Captured after pupil dilation: 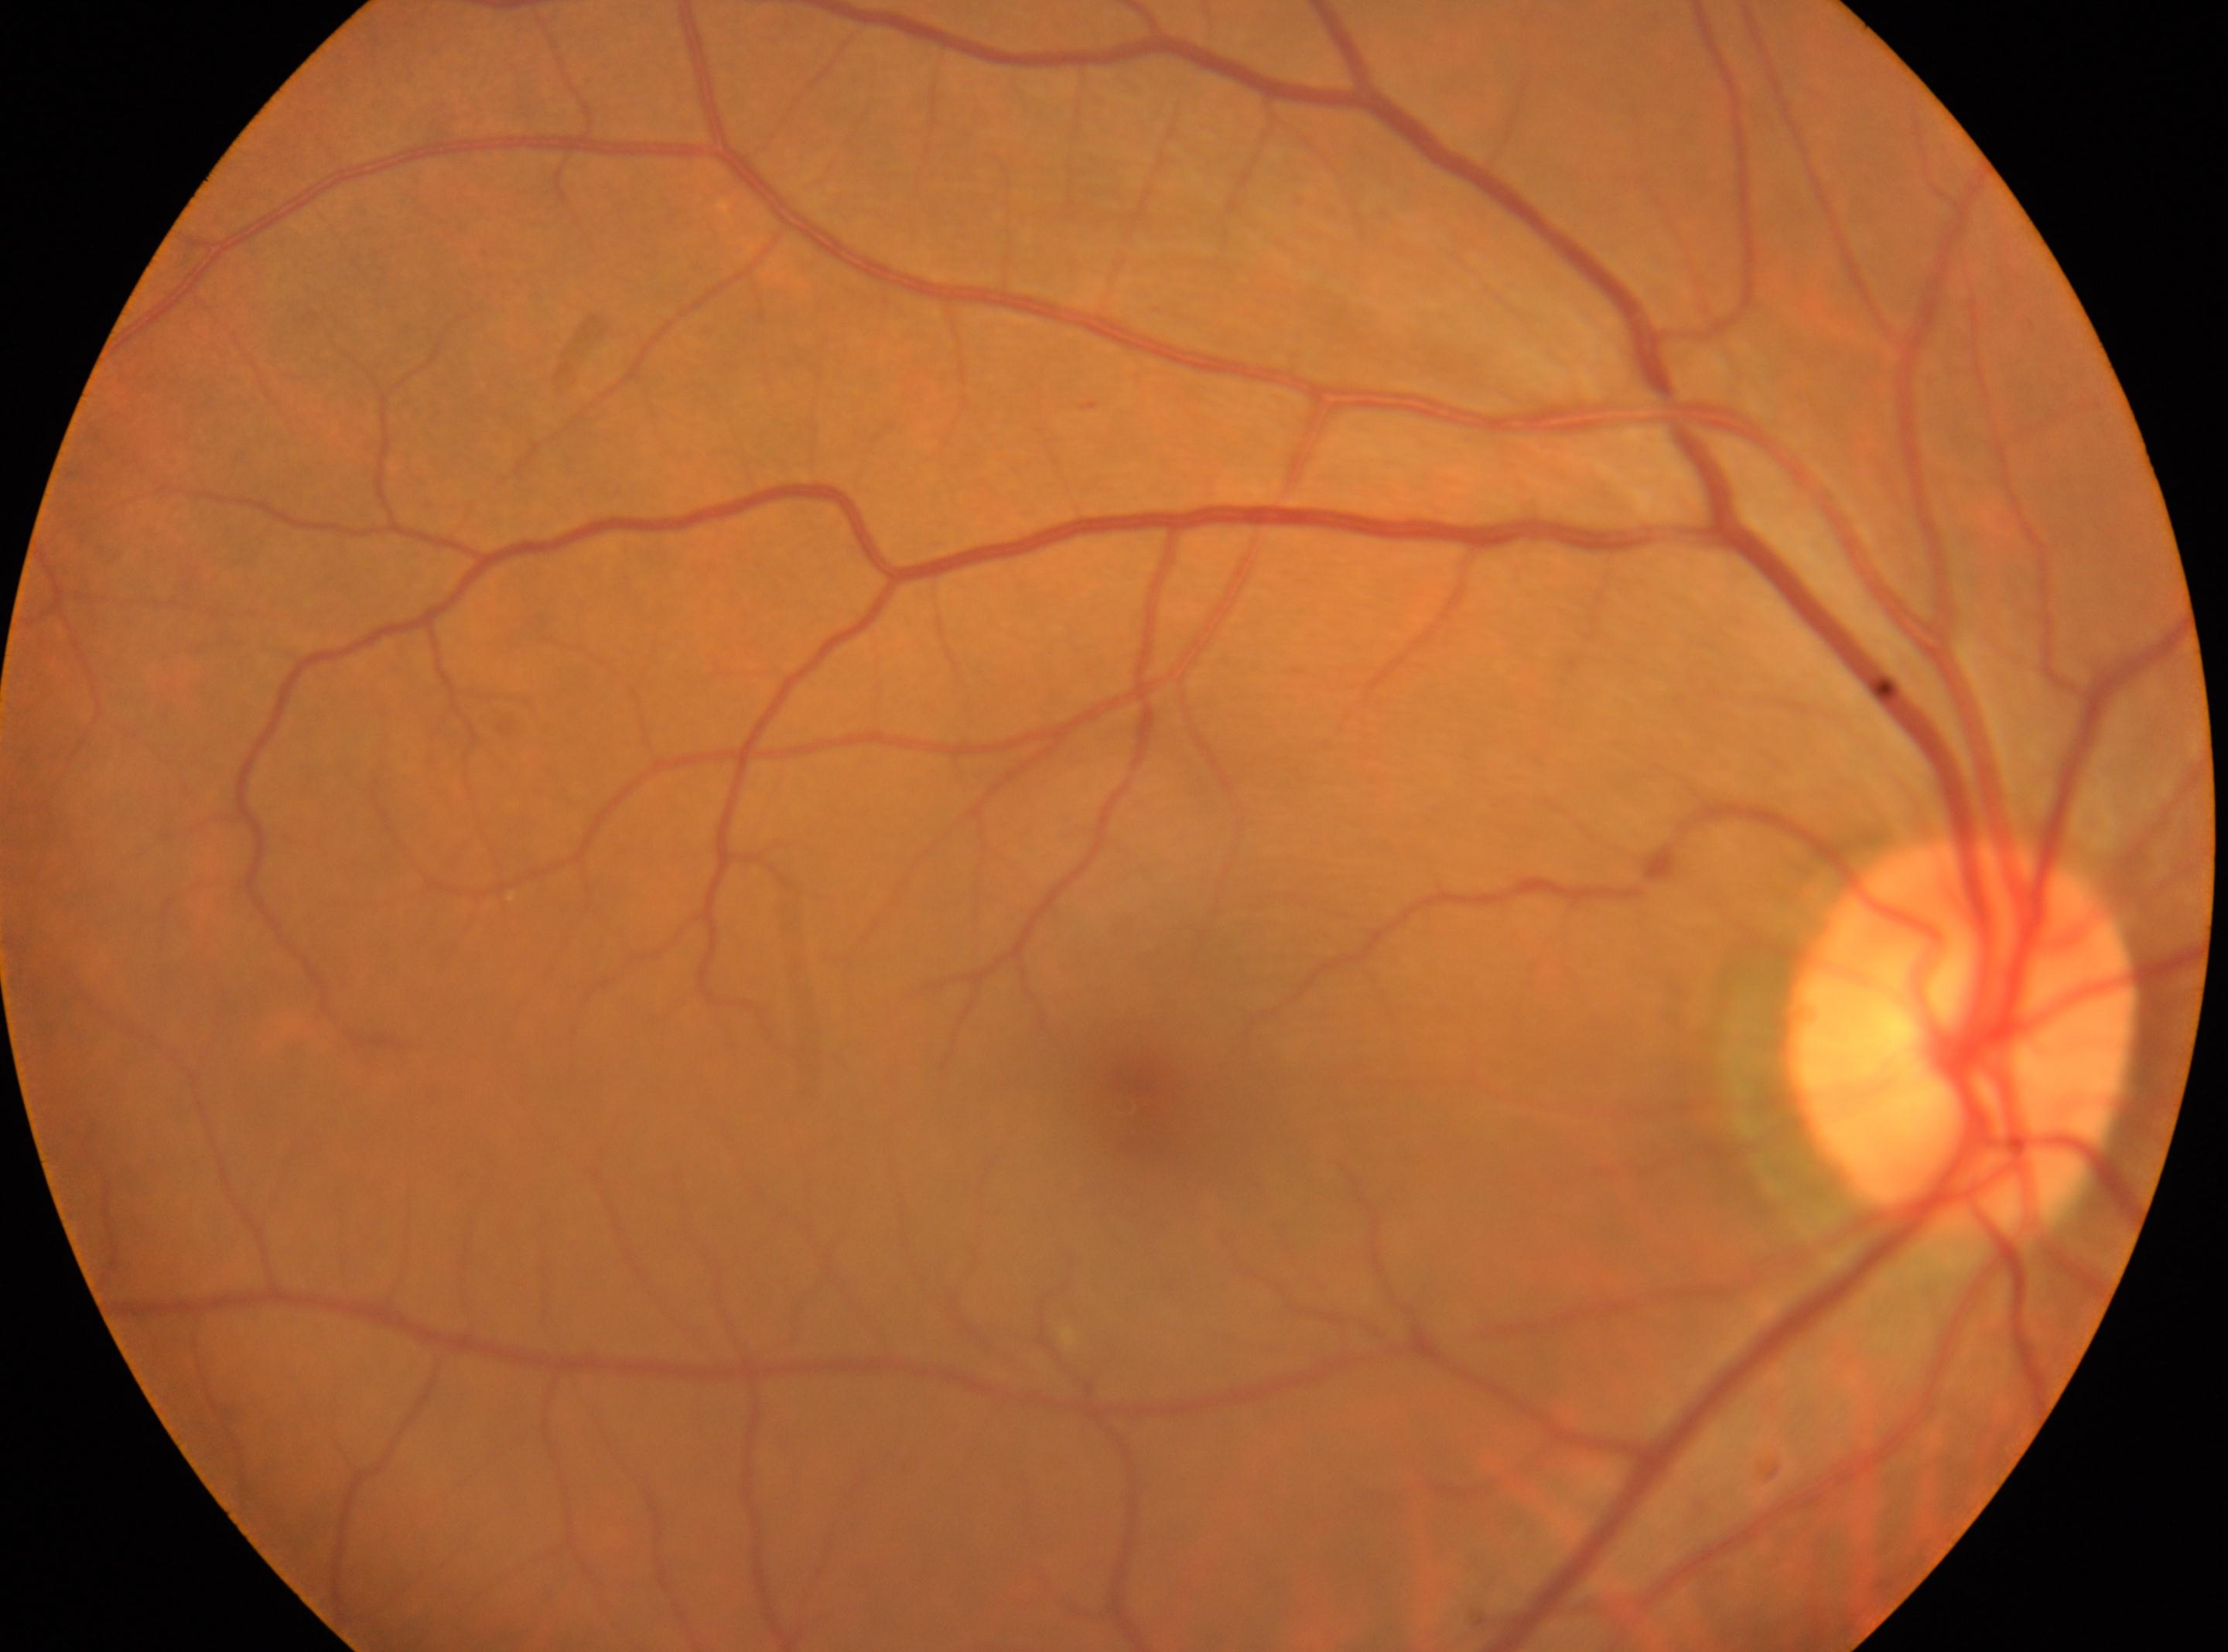

  eye: the right eye
  fovea: (1133, 1101)
  dr_grade: 0
  optic_disc: (1965, 1036)